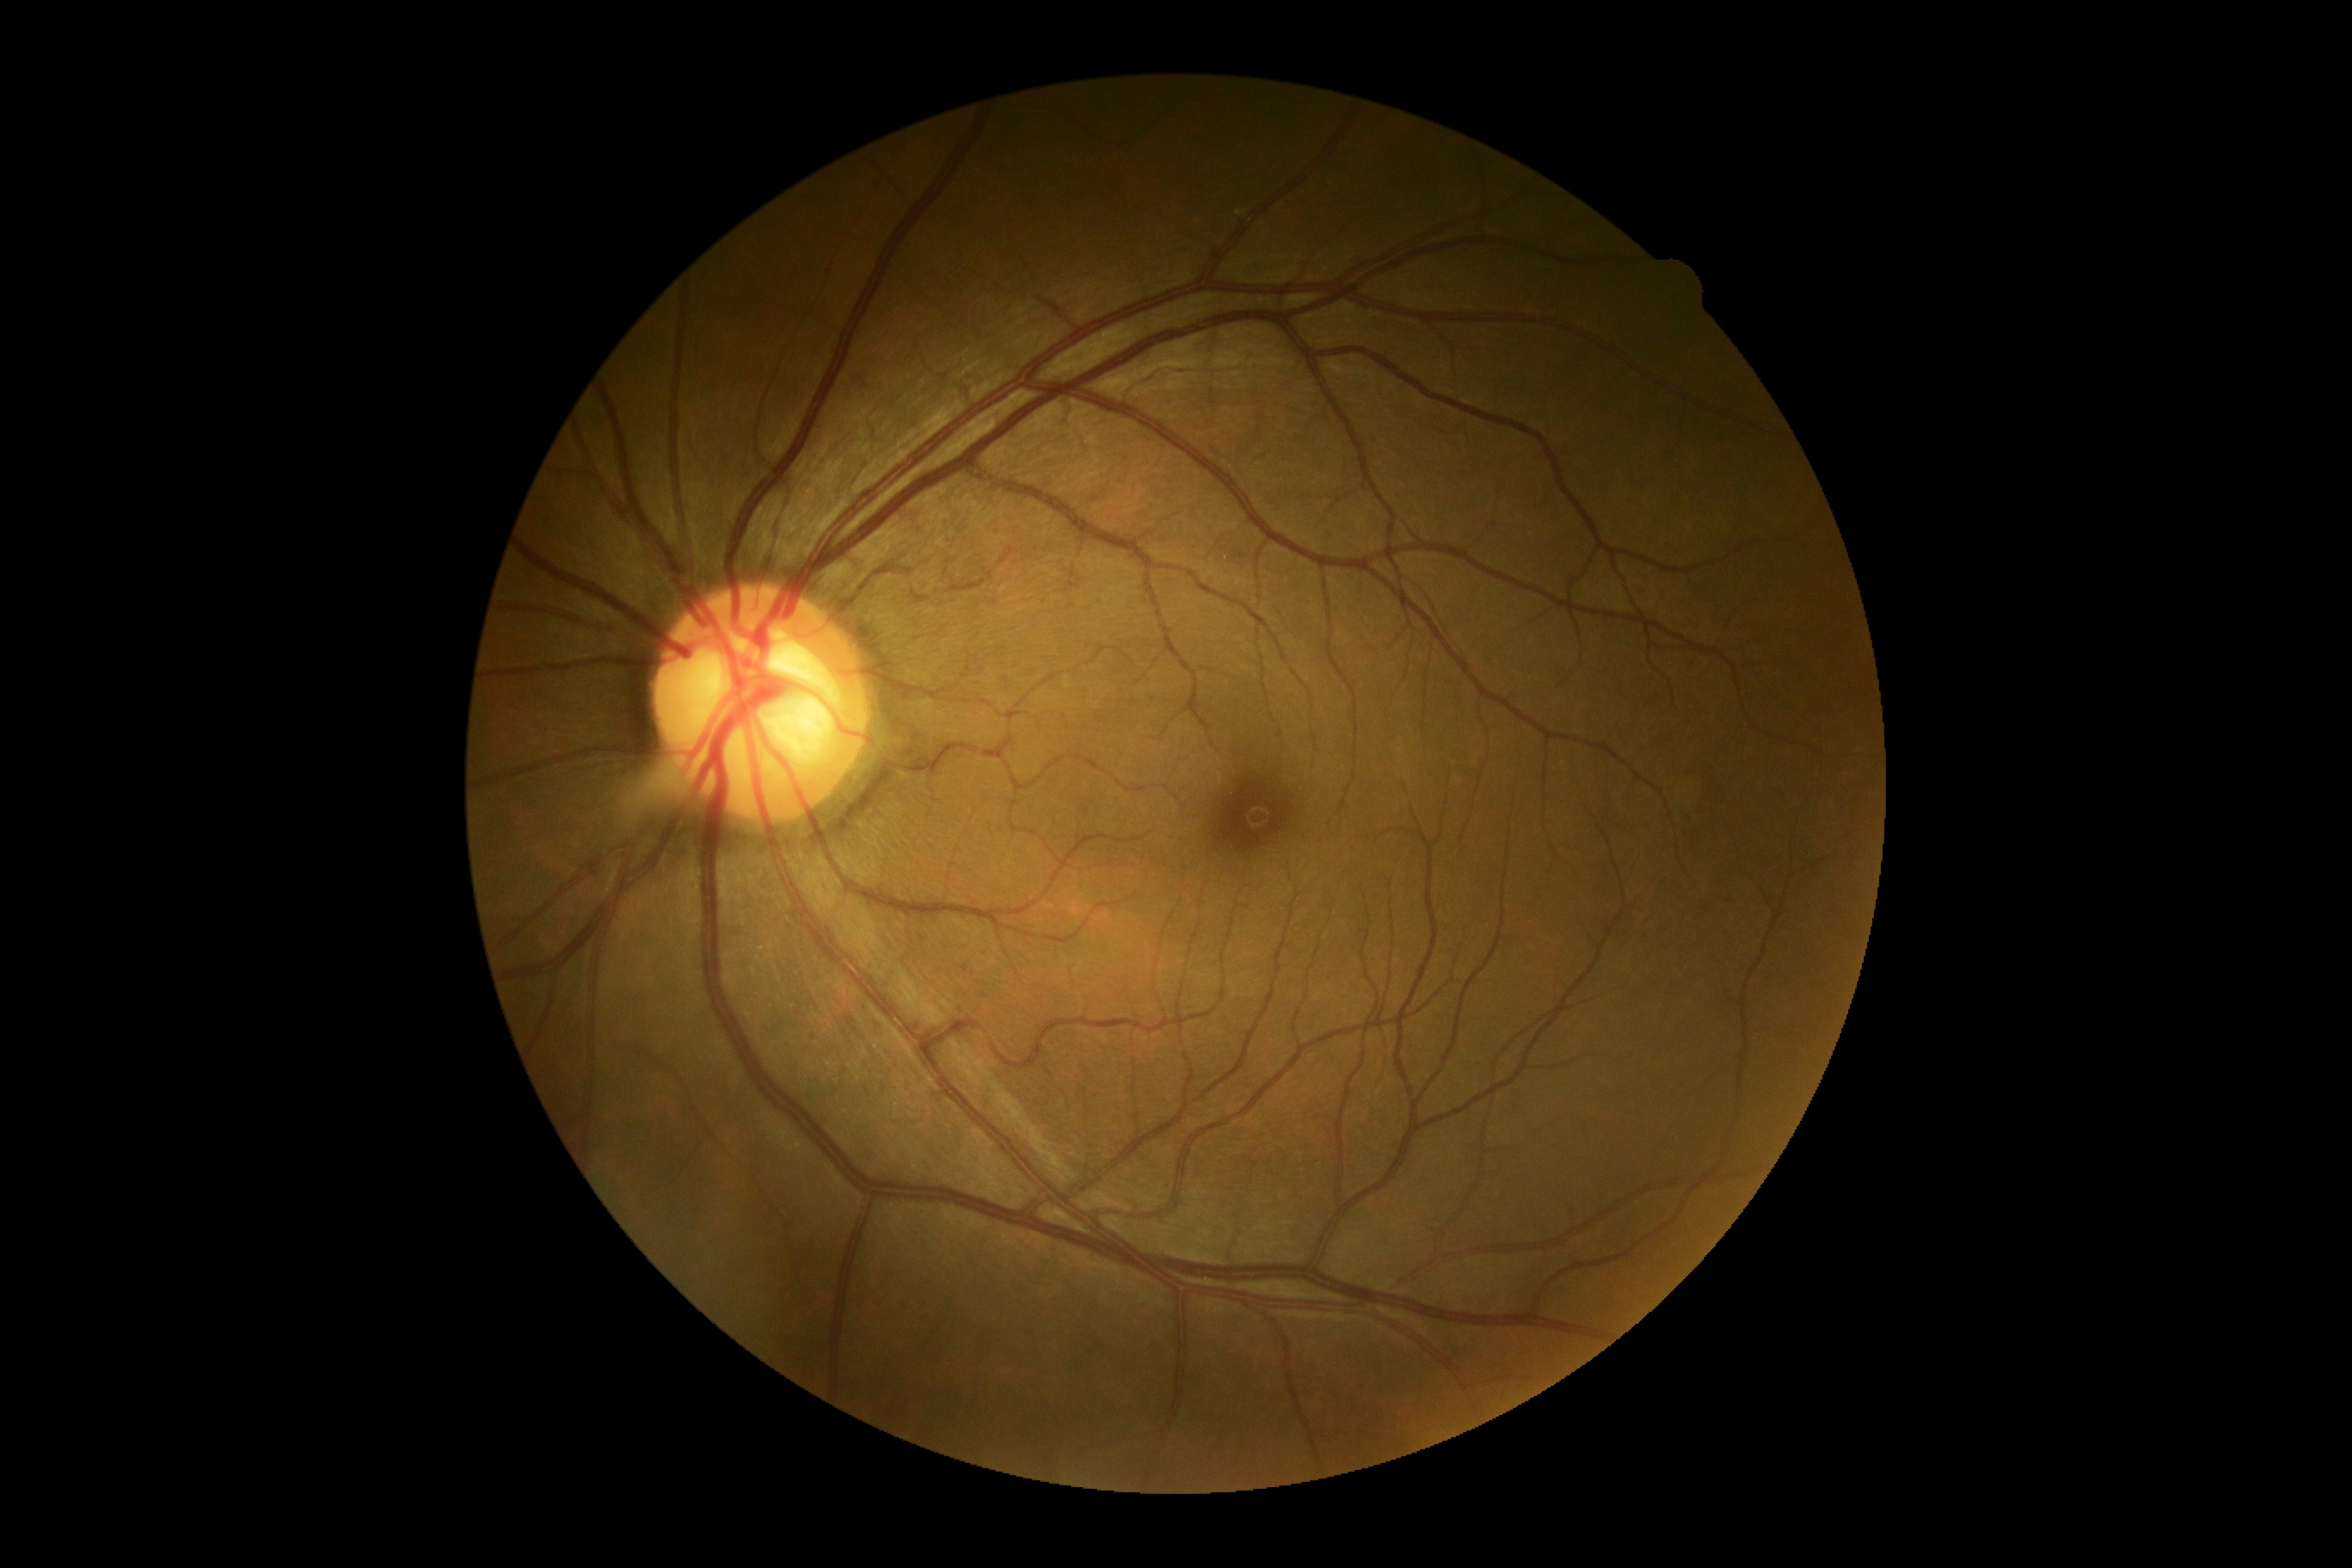
{
  "dr_grade": "0 (no apparent retinopathy)"
}